Wide-field contact fundus photograph of an infant:
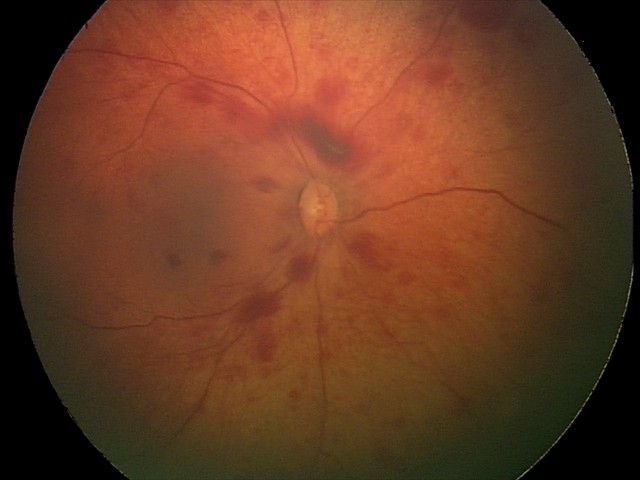
Diagnosis from this screening exam: retinal hemorrhages.